45° field of view · modified Davis classification · 848x848px · NIDEK AFC-230 · nonmydriatic — 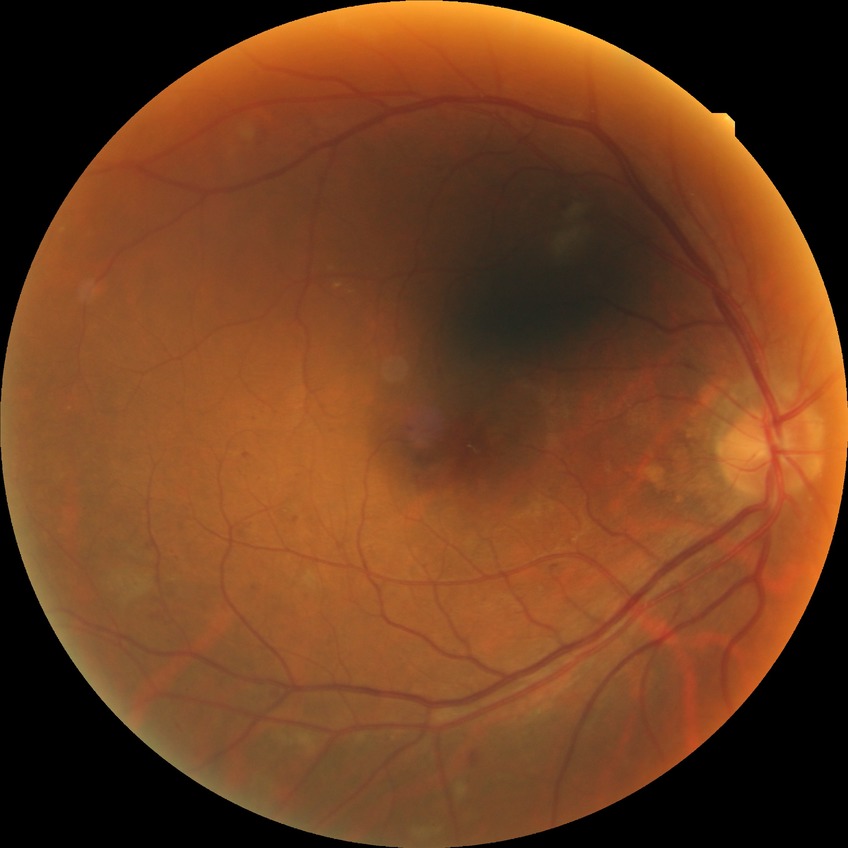
diabetic retinopathy (DR): SDR (simple diabetic retinopathy)